50° field of view; central posterior field; captured after pupil dilation
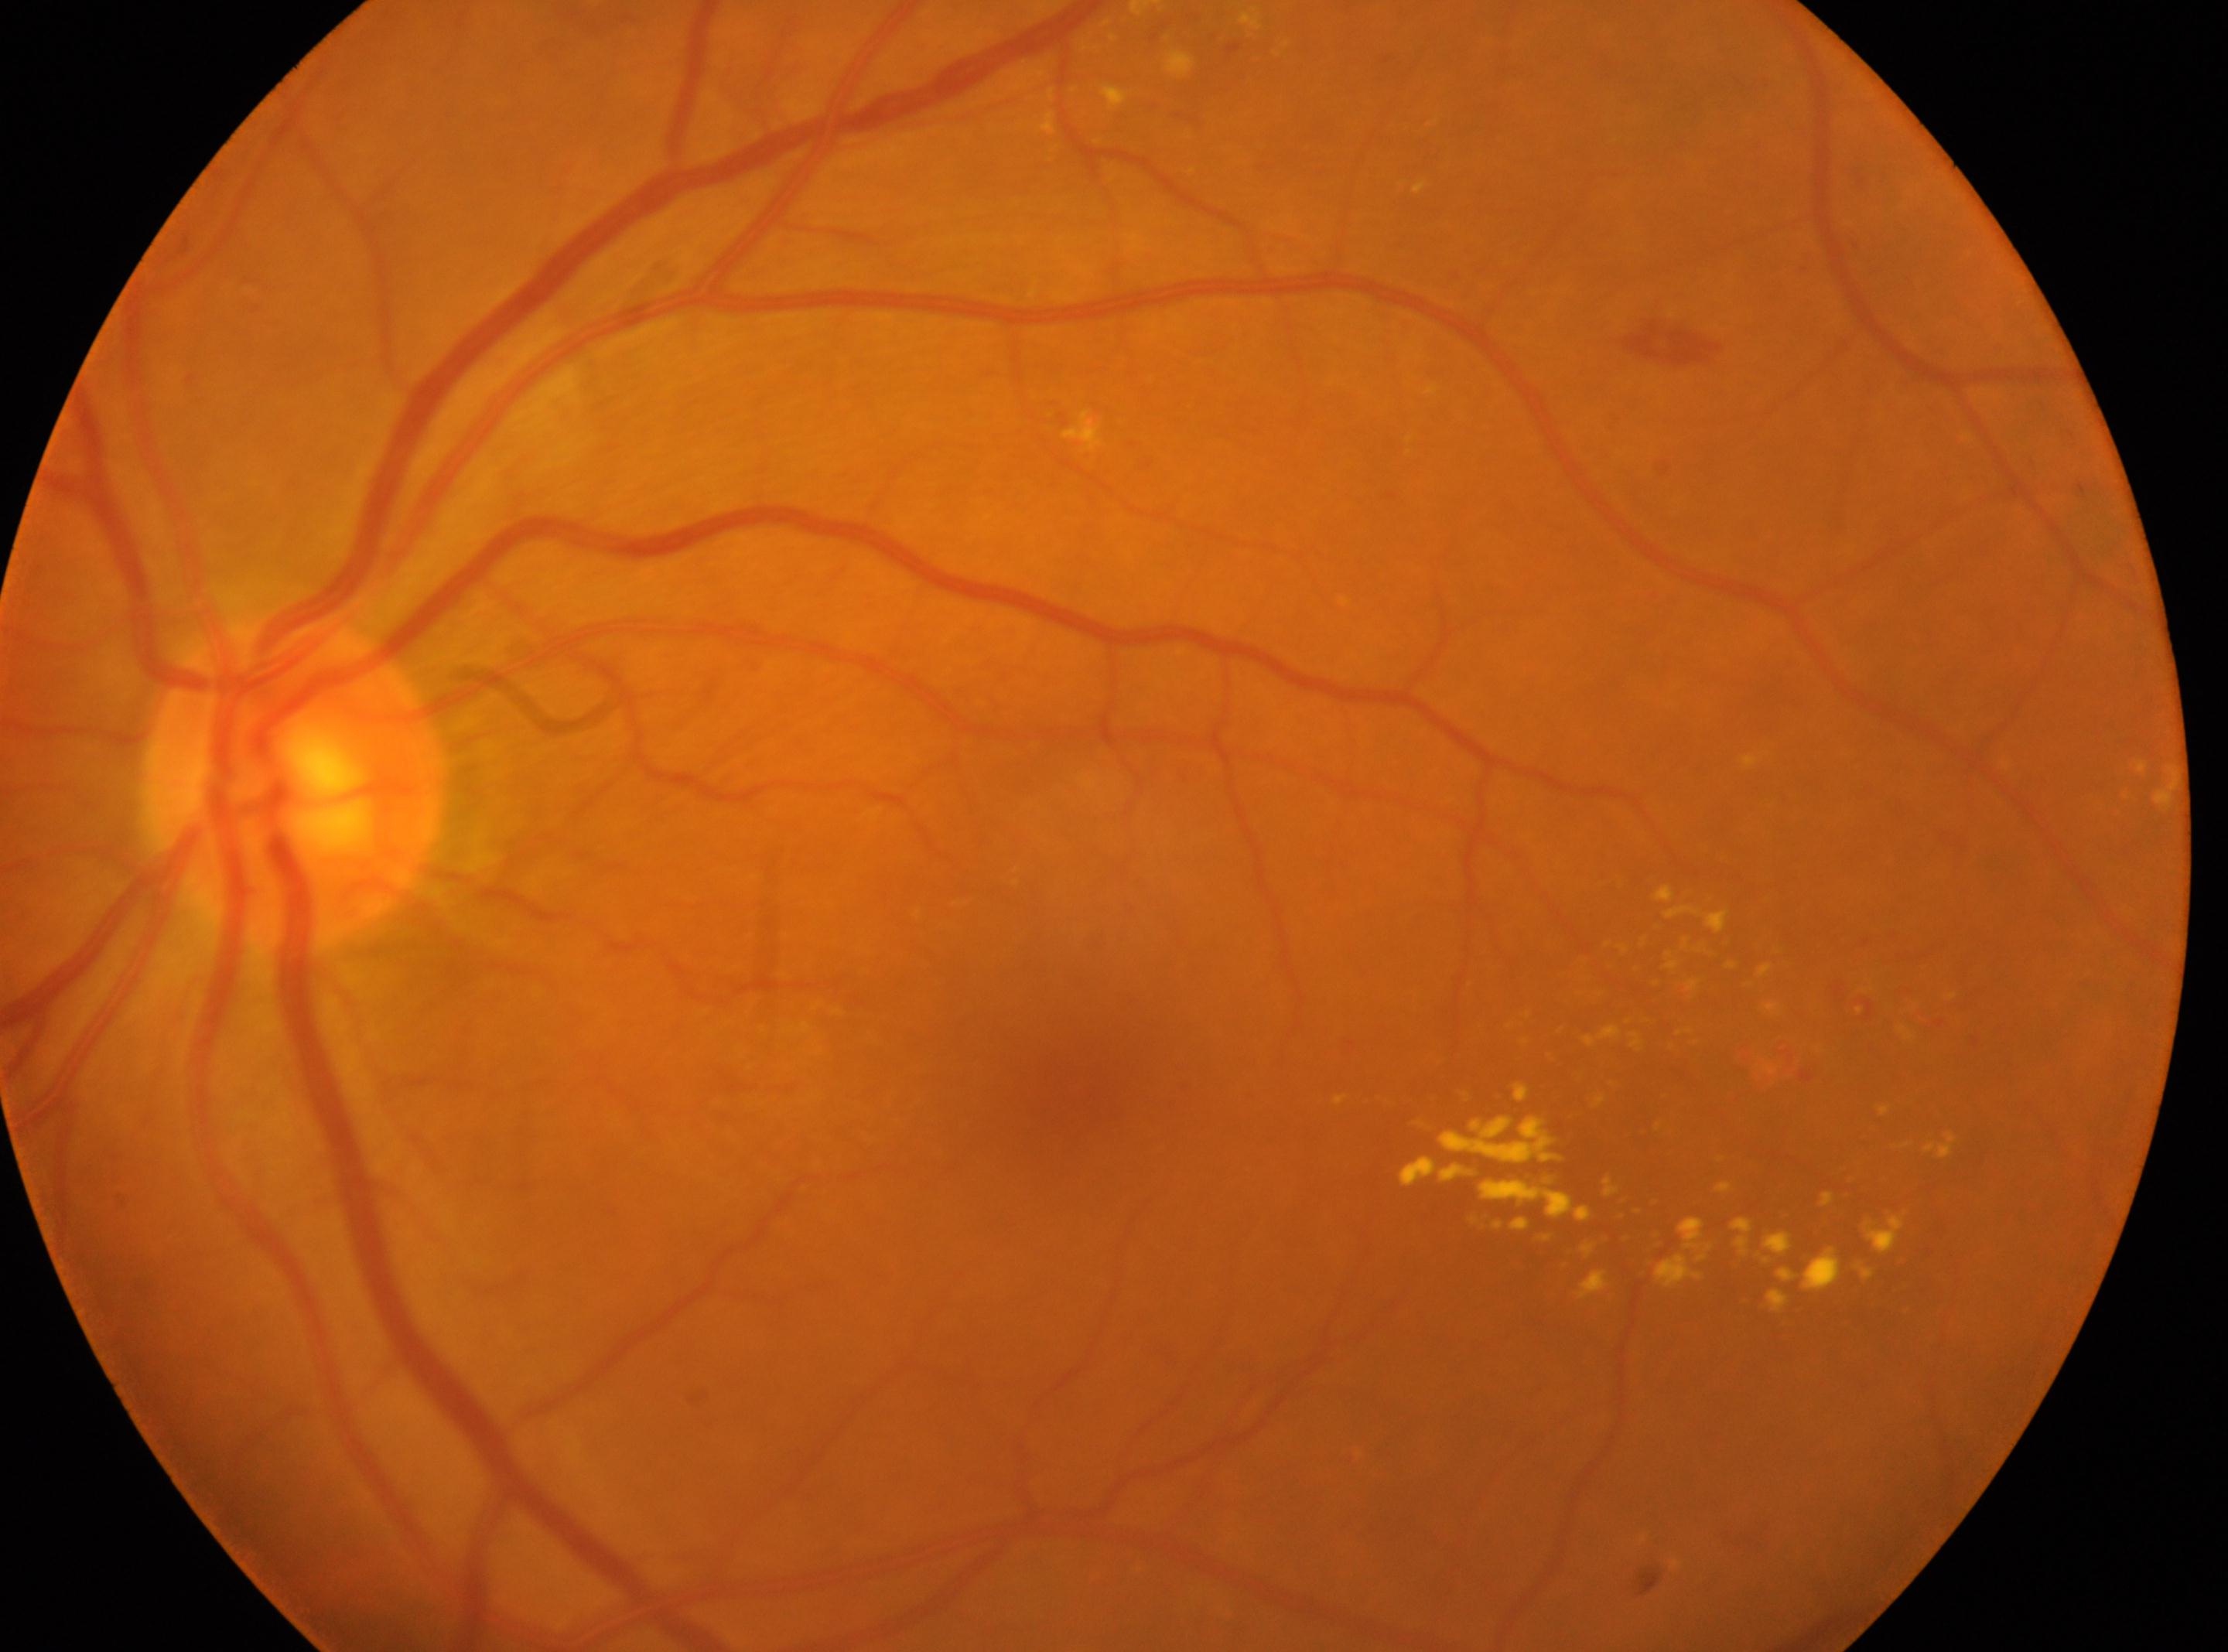
eye: oculus sinister
dr_category: non-proliferative diabetic retinopathy
fovea: (1082, 1091)
dr_grade: 2
optic_disc: (294, 783)